848 by 848 pixels.
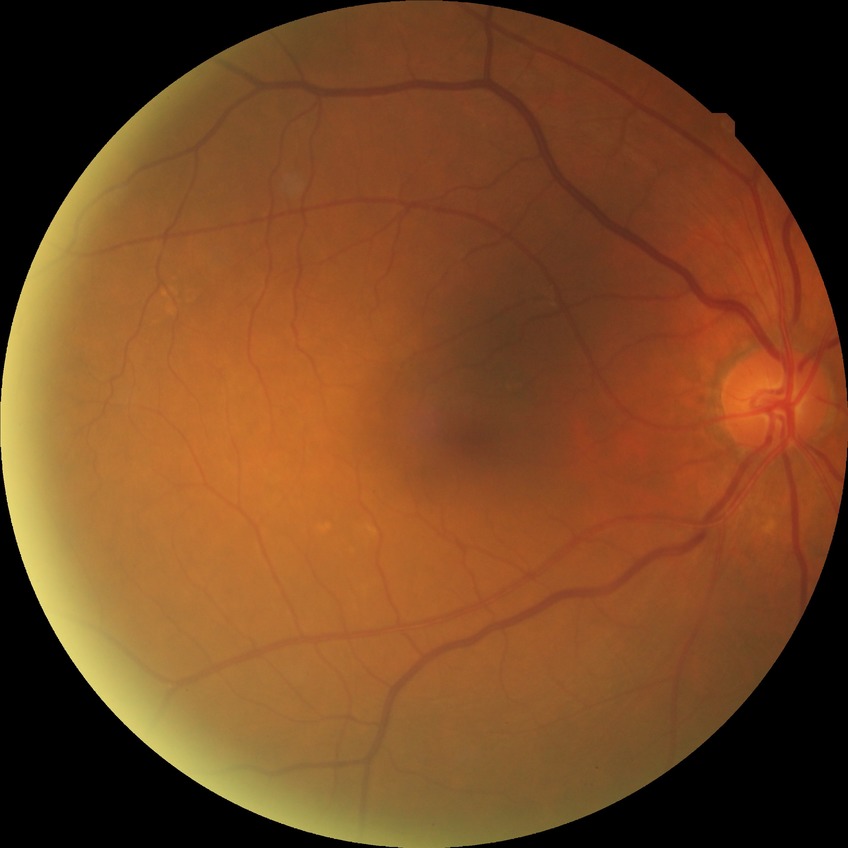
Diabetic retinopathy (DR) is no diabetic retinopathy (NDR).